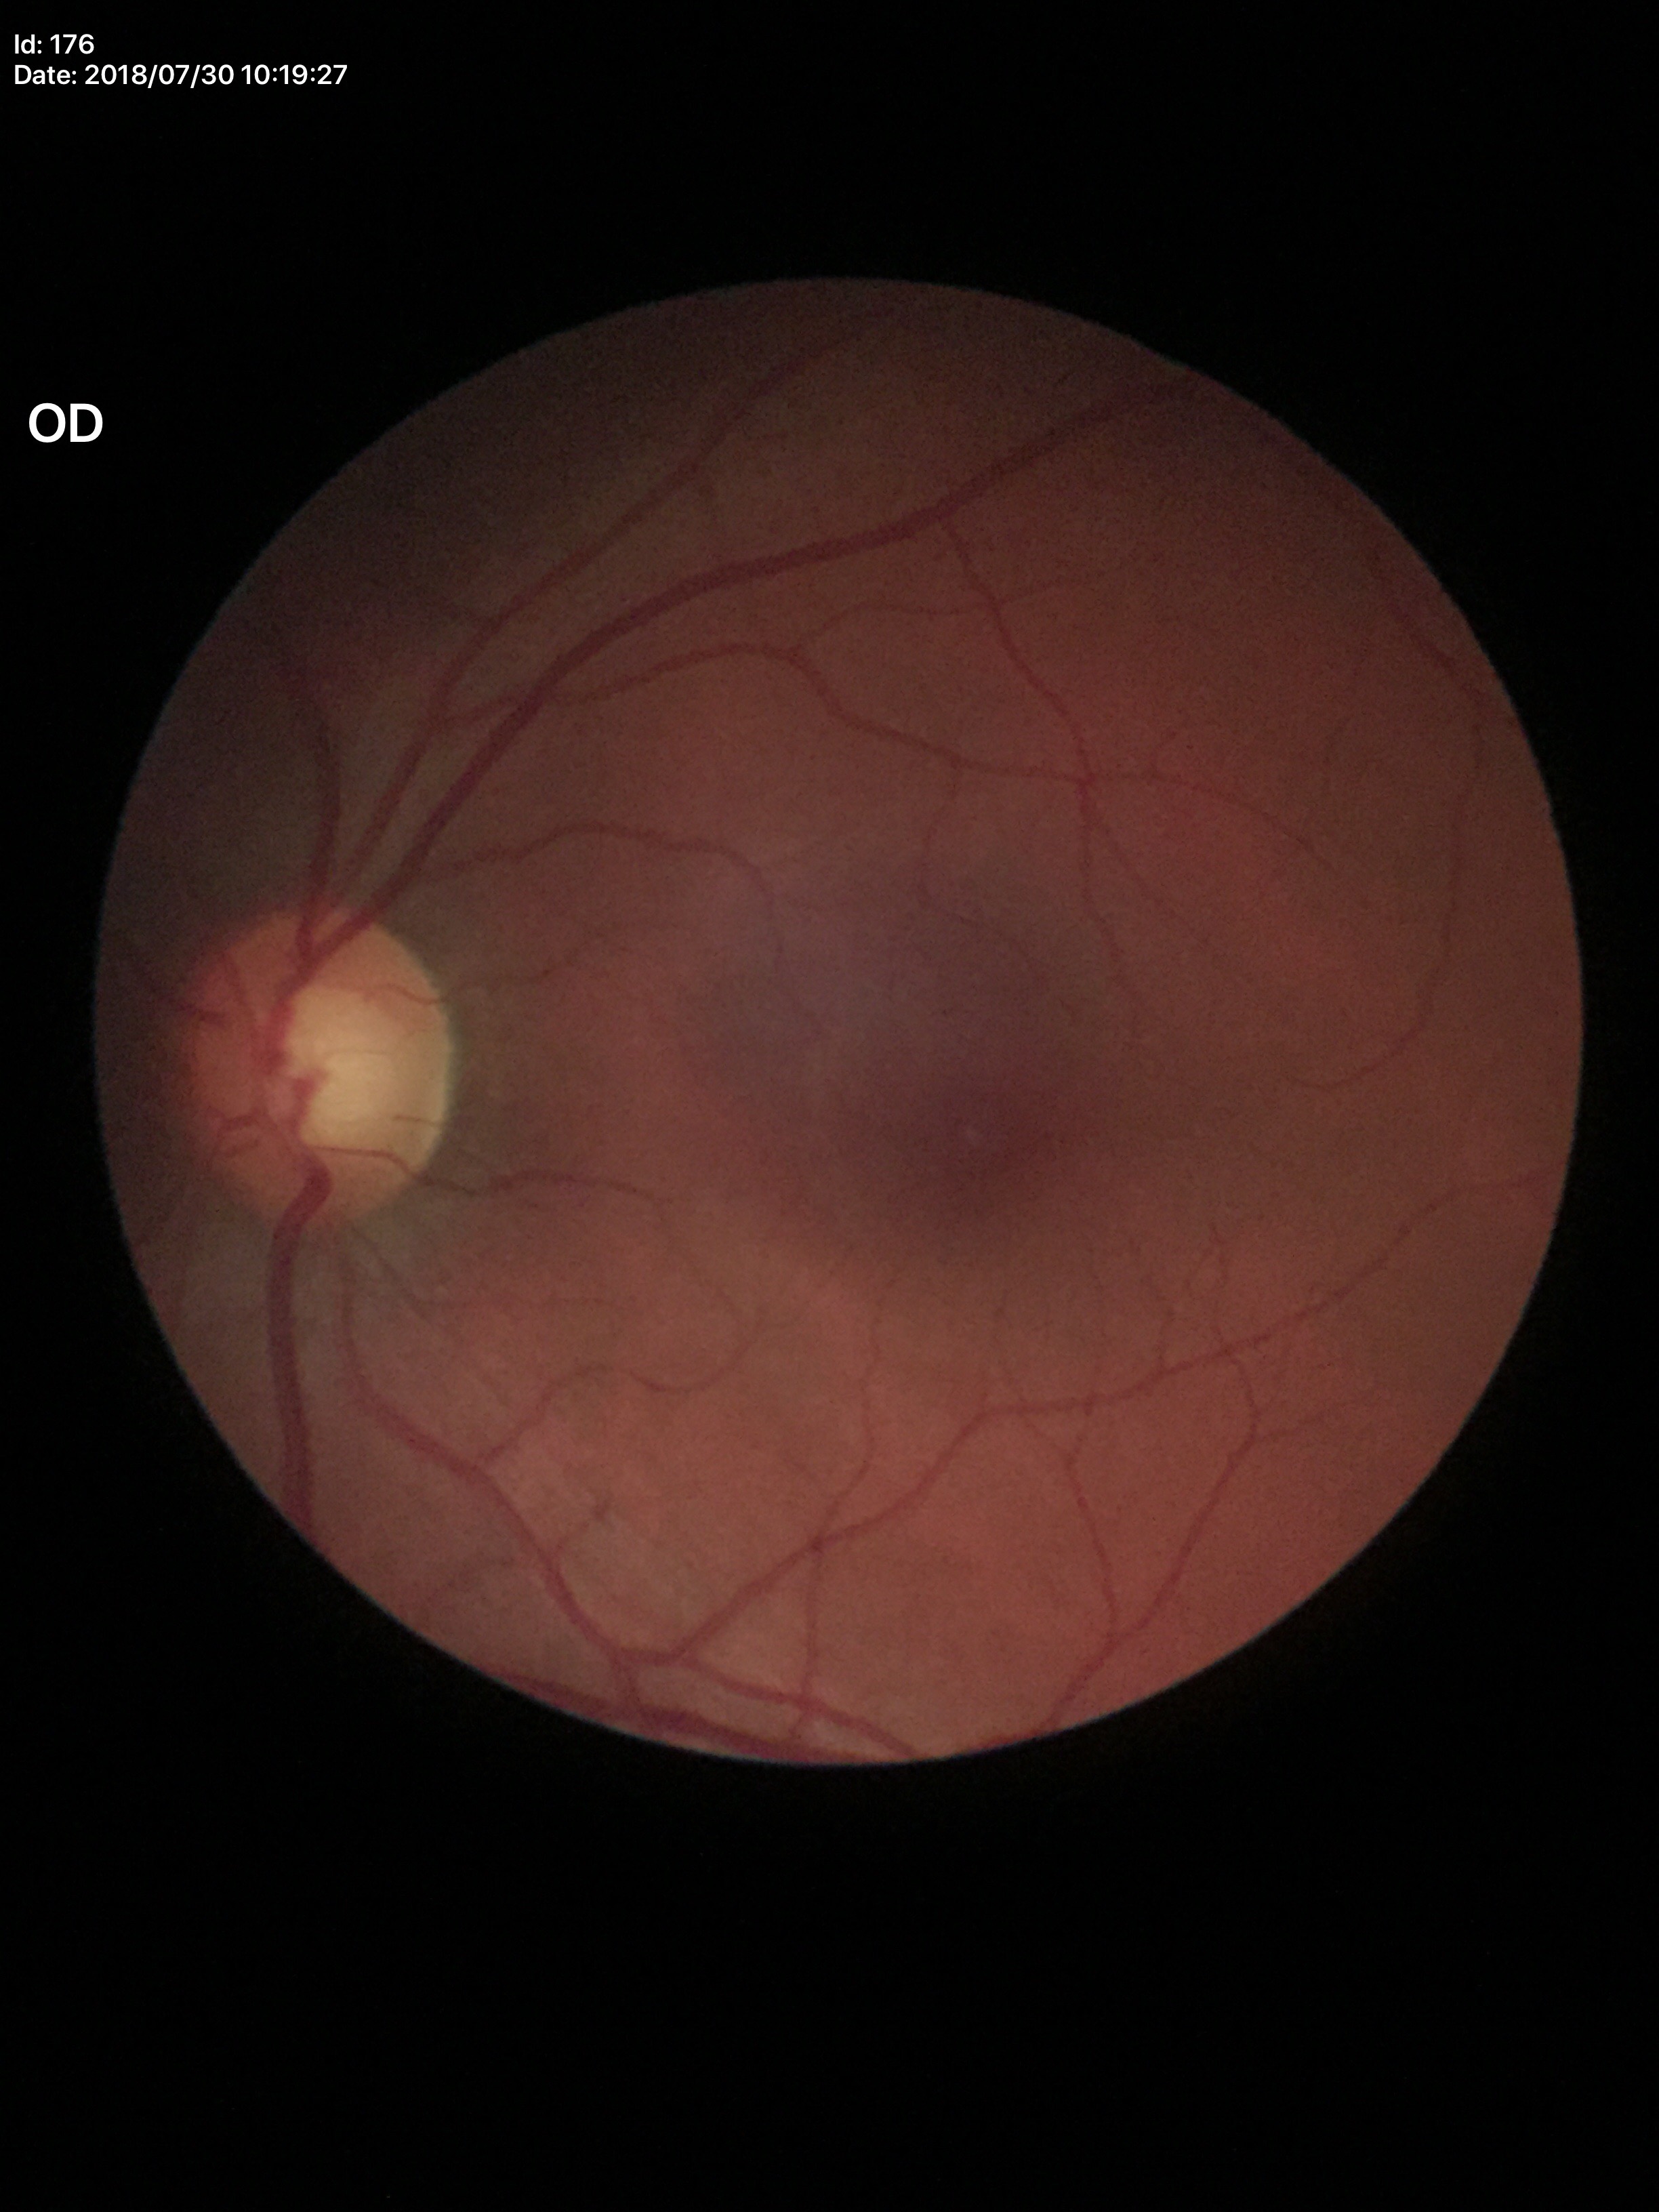 Q: Glaucoma screening result?
A: negative
Q: Vertical CDR?
A: 0.56